Ultra-widefield fundus photograph. FOV: 200 degrees.
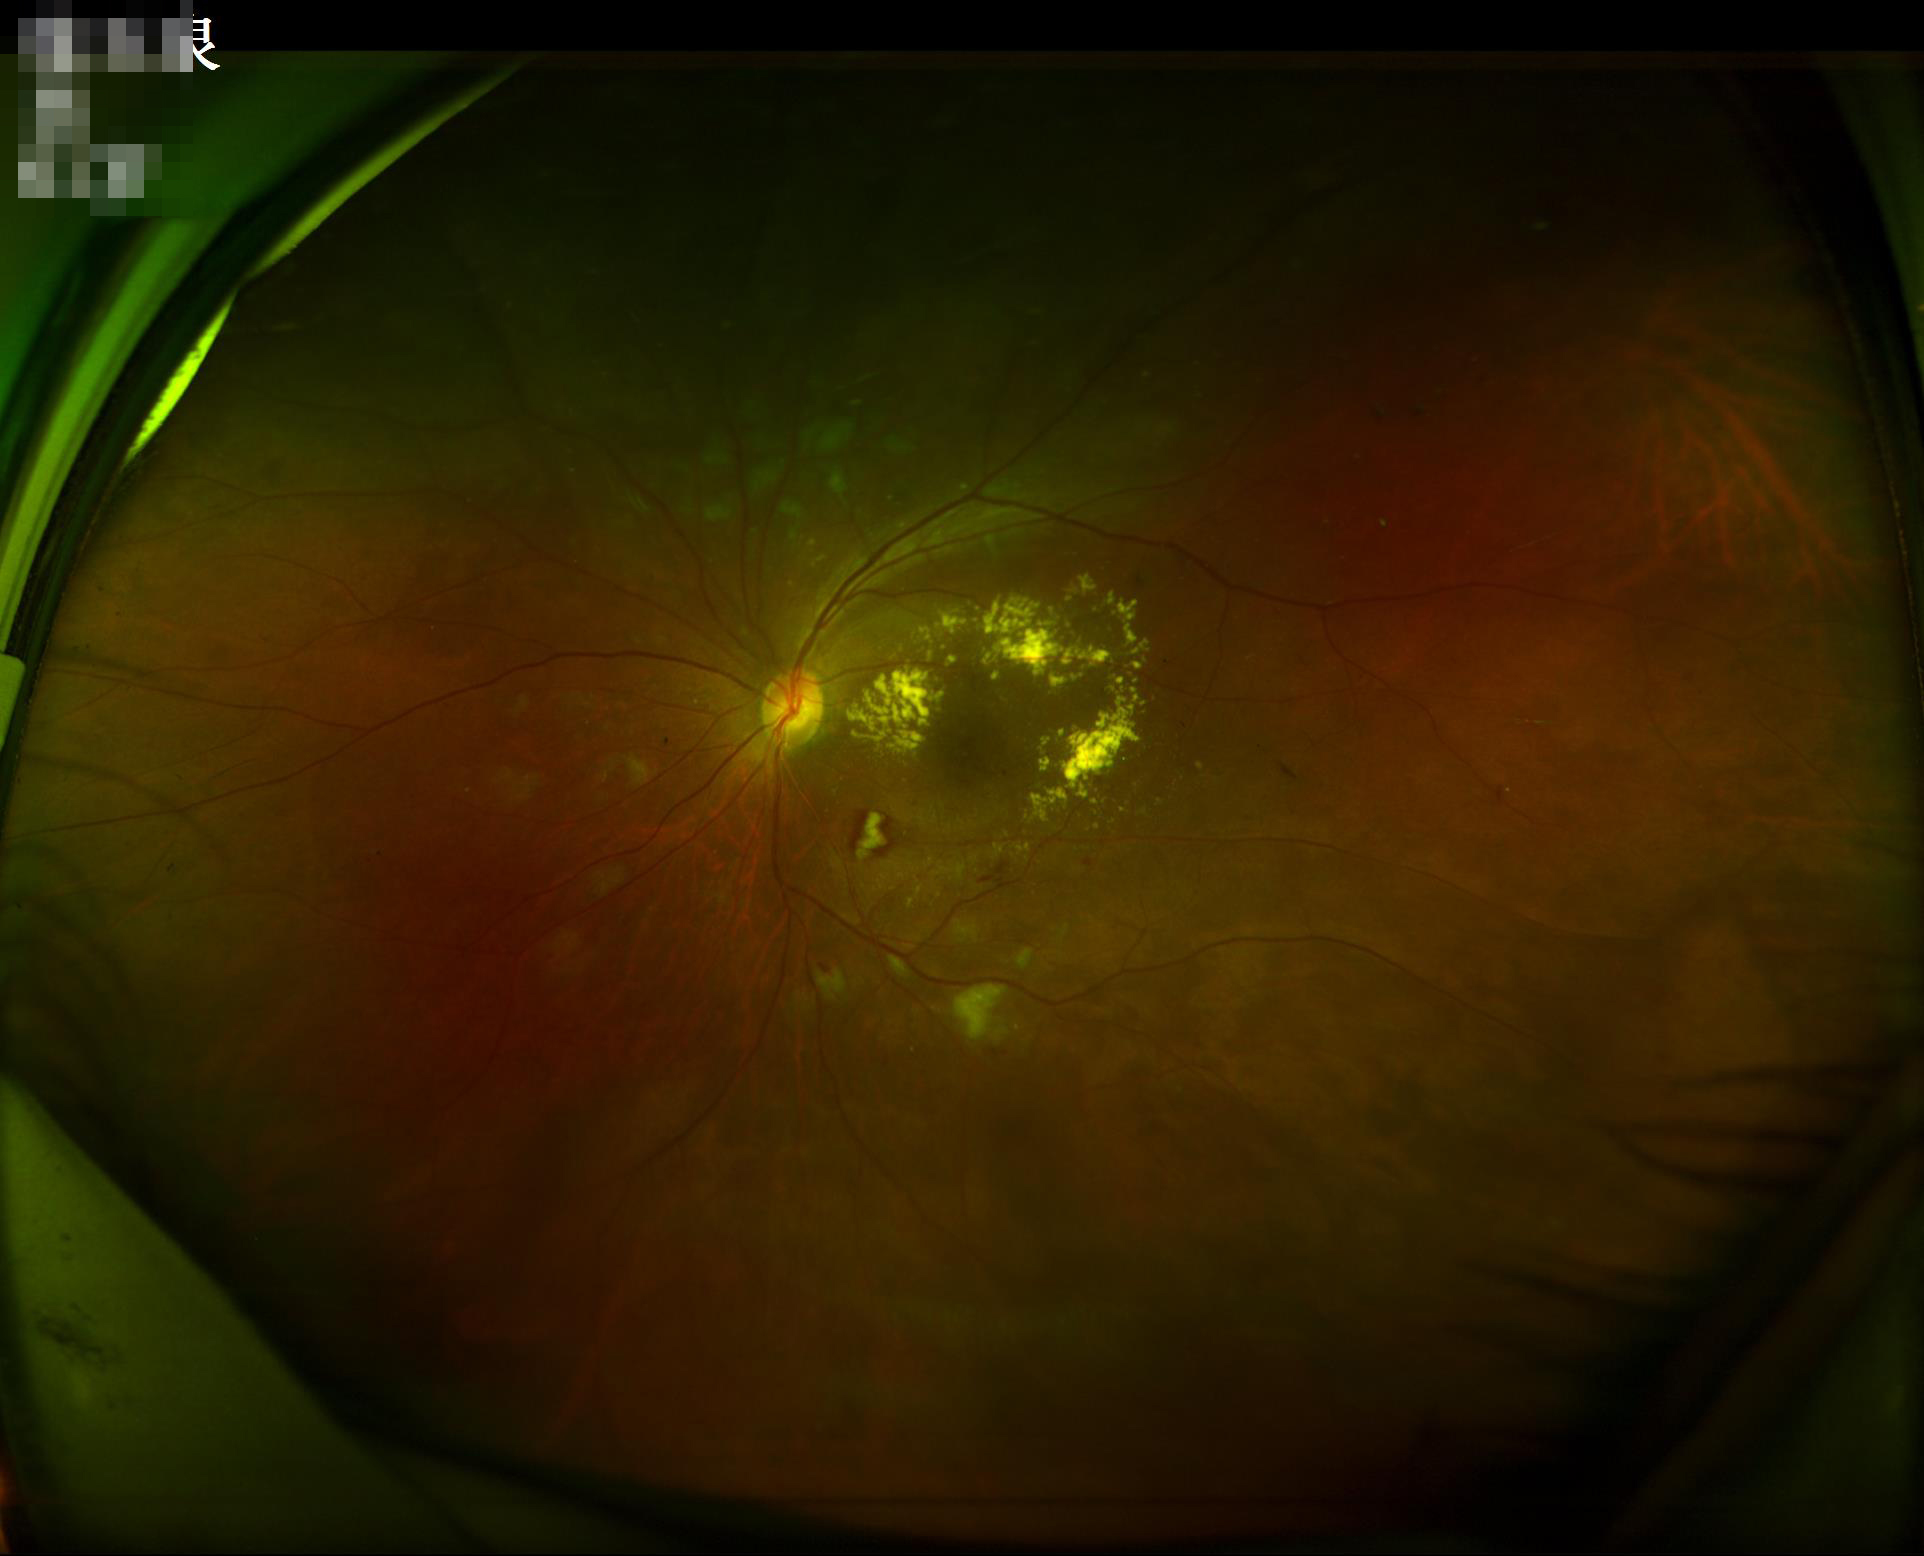
Acceptable image quality.